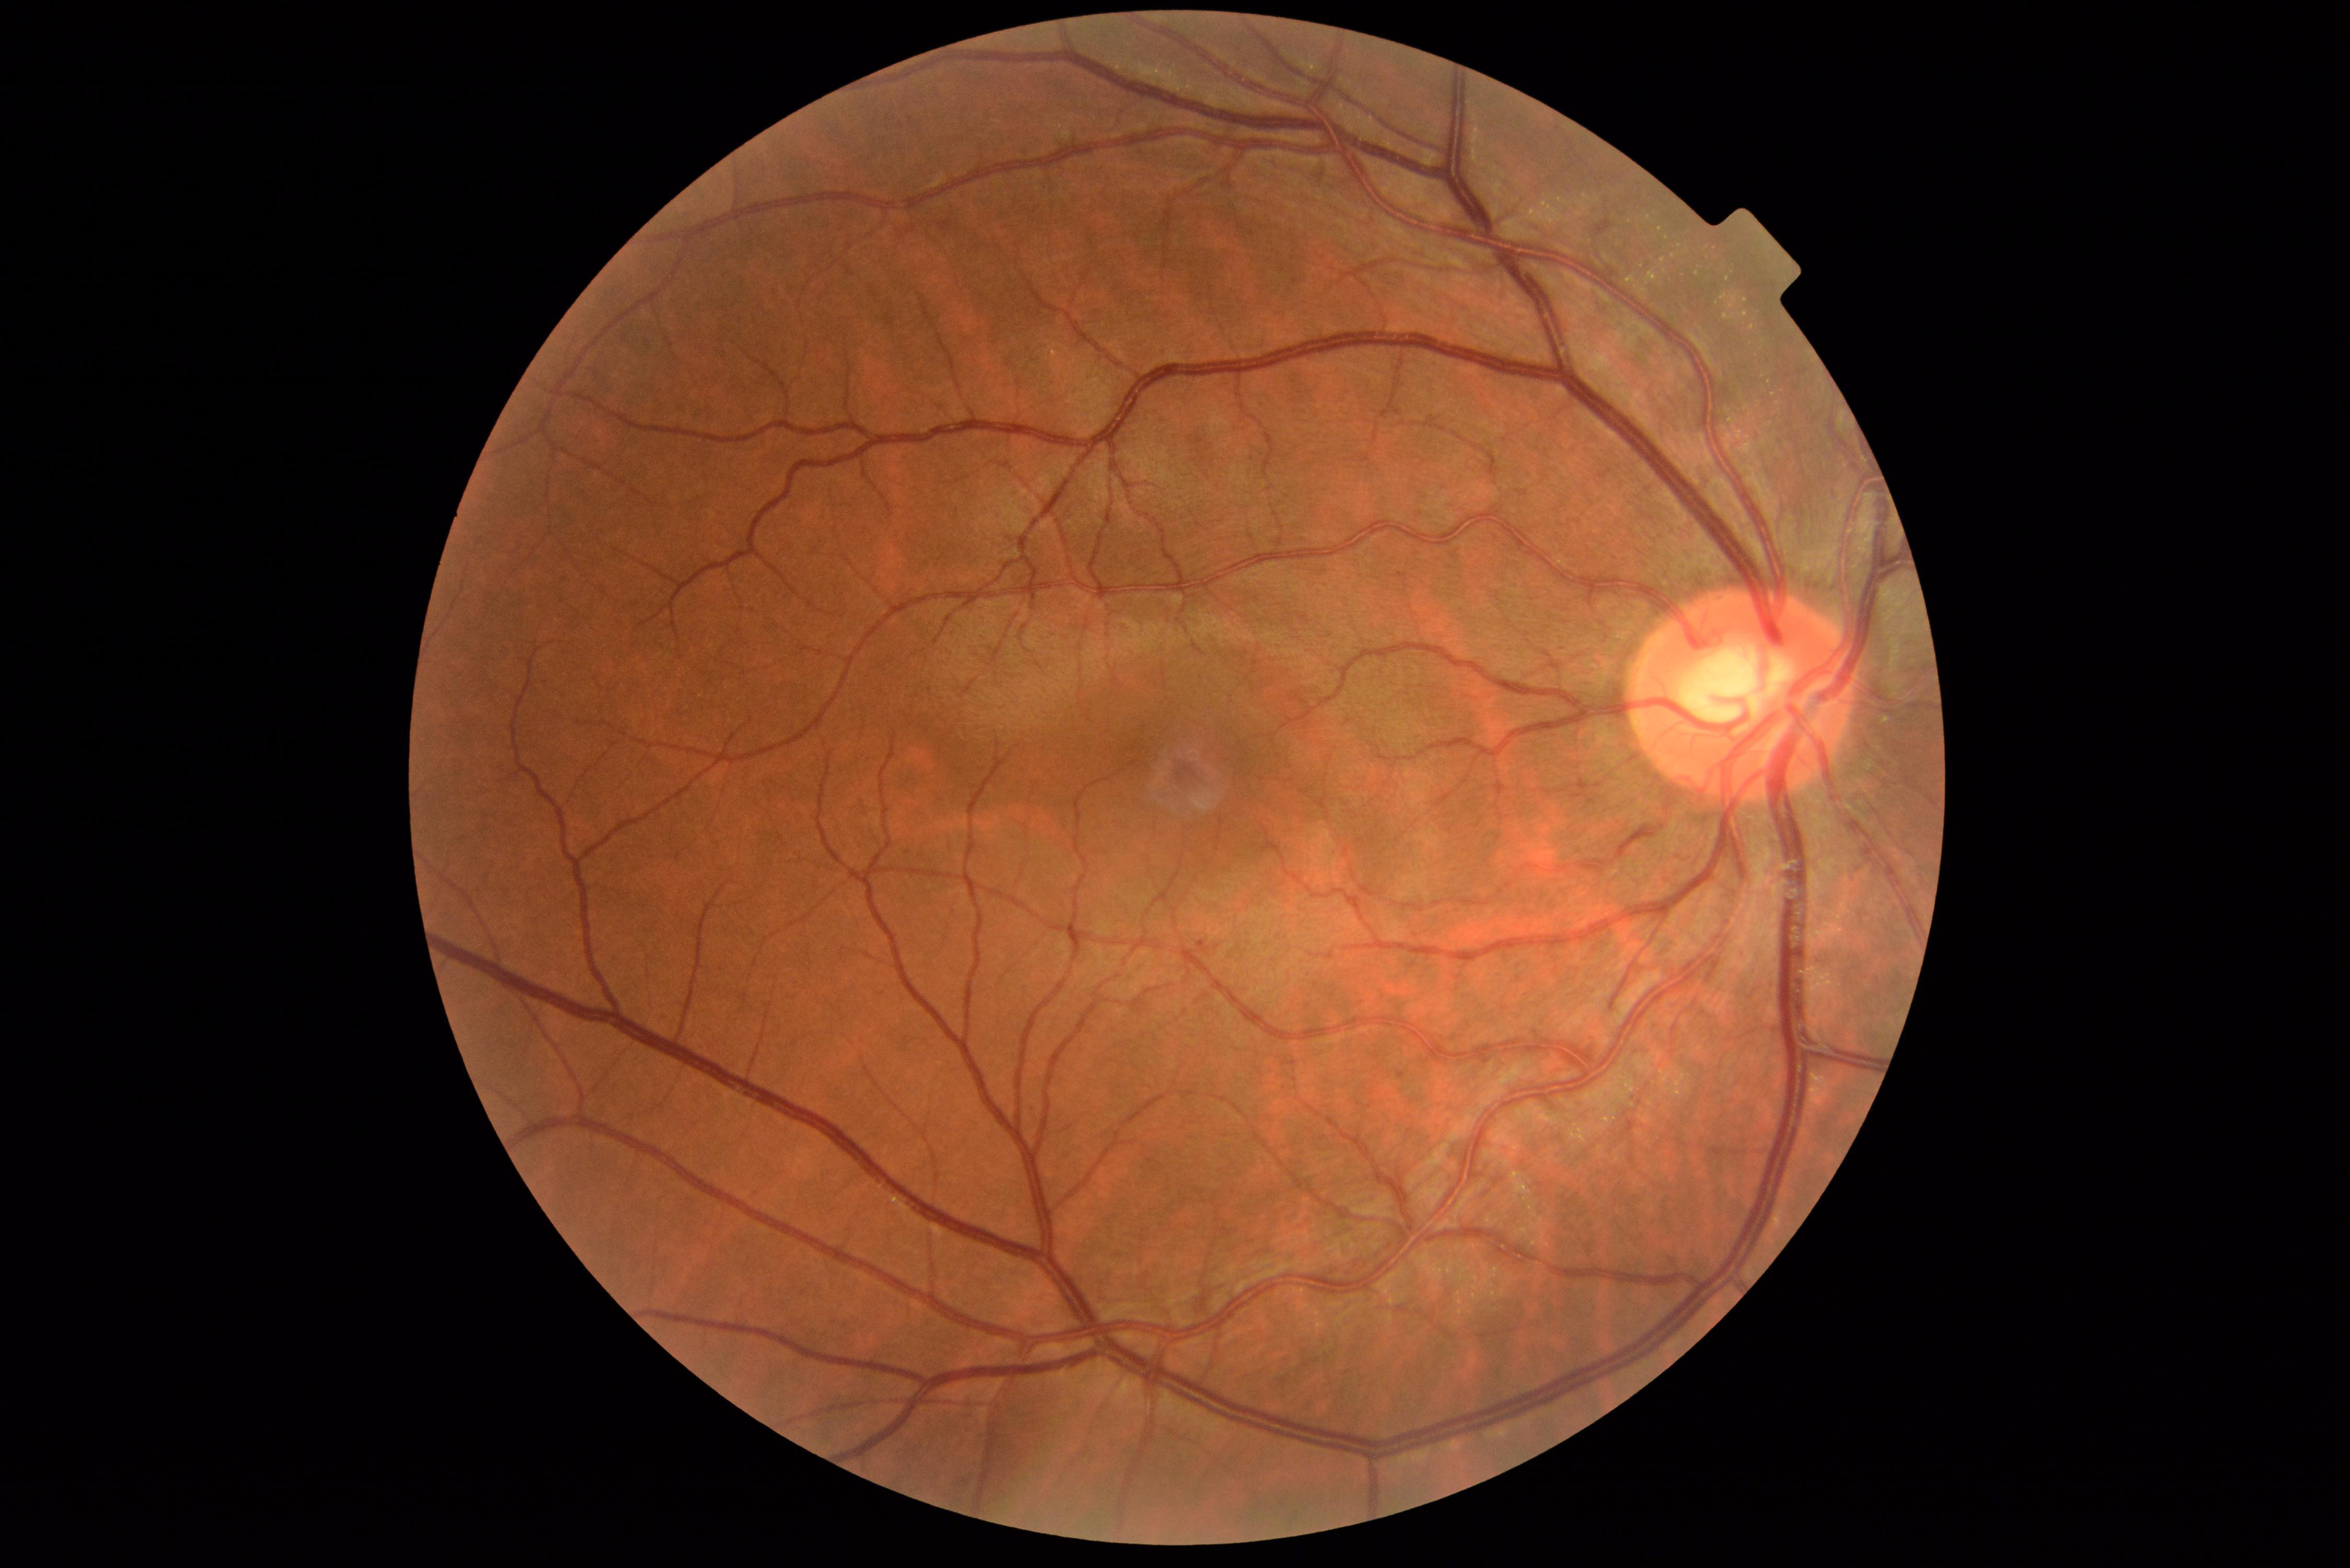 Diabetic retinopathy: mild non-proliferative diabetic retinopathy (grade 1).